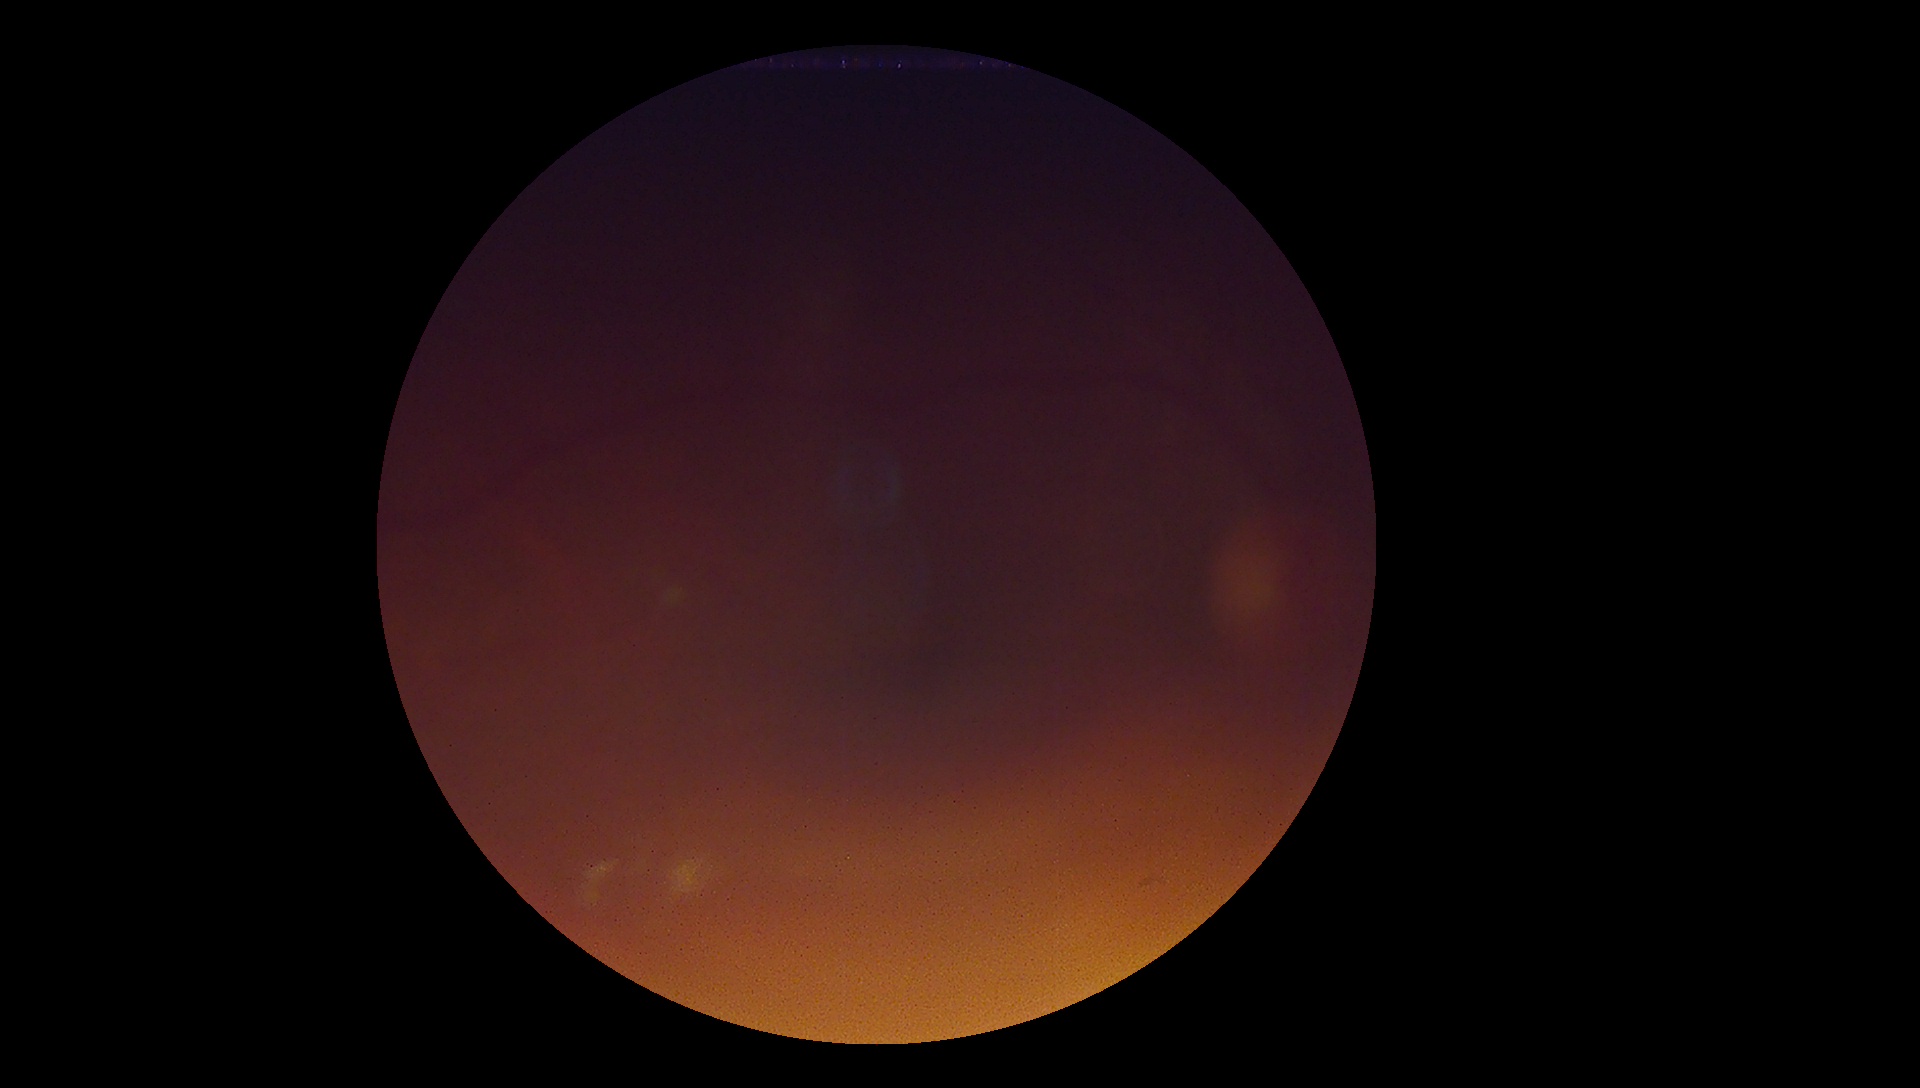 Findings:
– retinopathy — ungradable